Pediatric retinal photograph (wide-field); acquired on the Phoenix ICON.
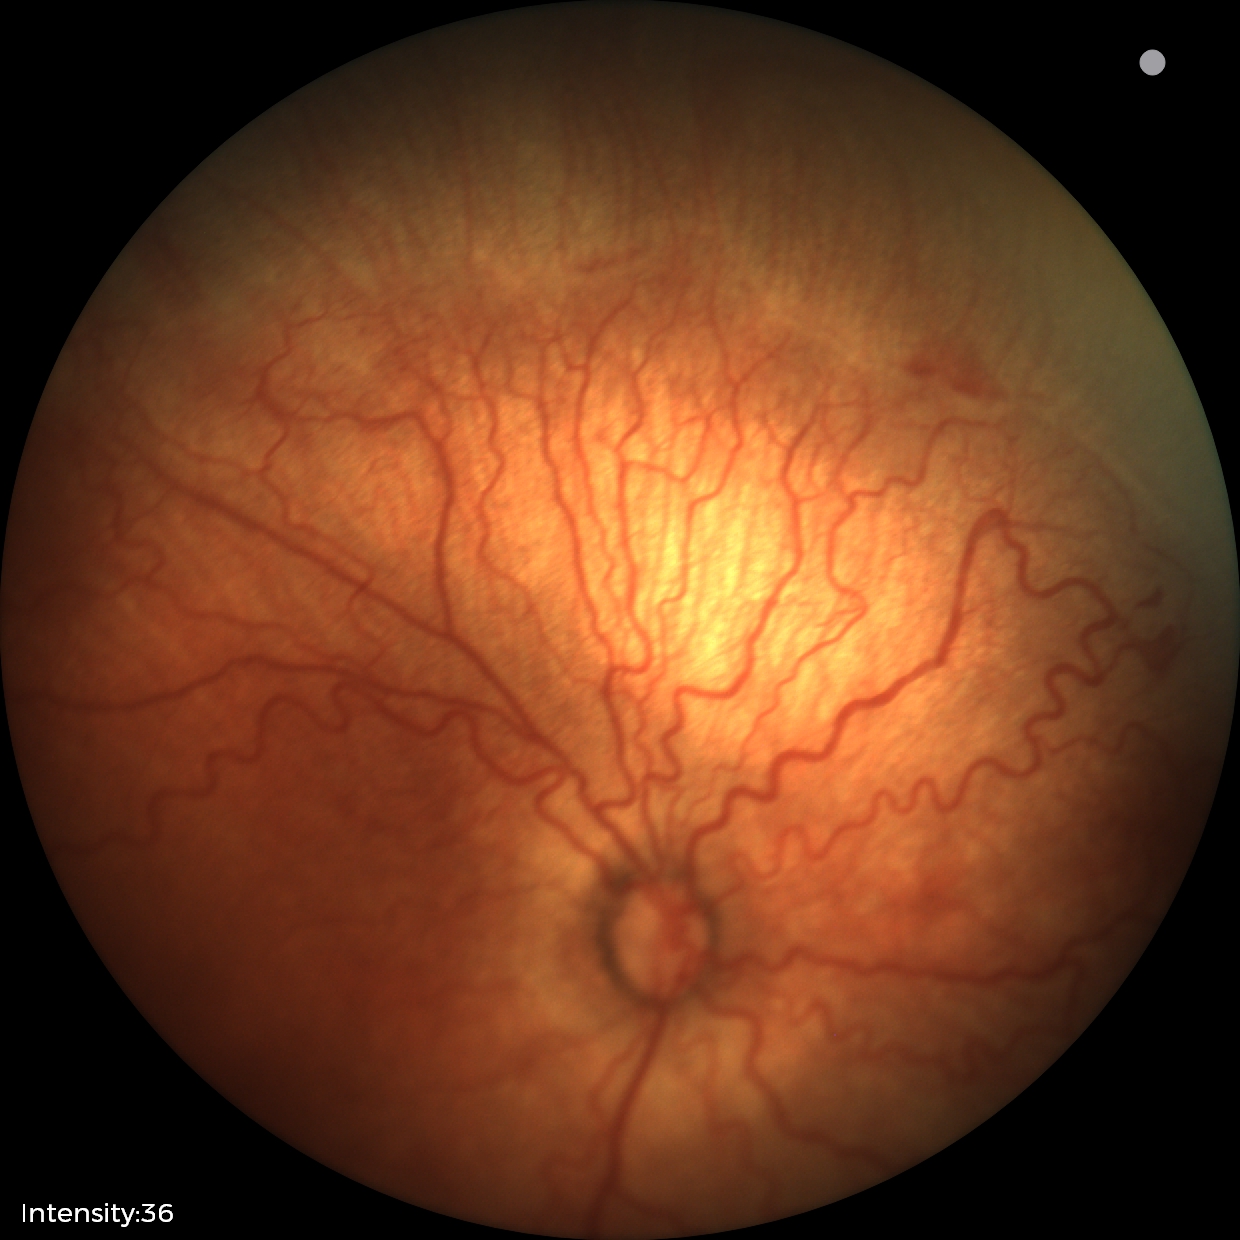

Q: What is the screening diagnosis?
A: retinopathy of prematurity (ROP) stage 2
Q: What is the plus-form classification?
A: plus disease